2352 by 1568 pixels:
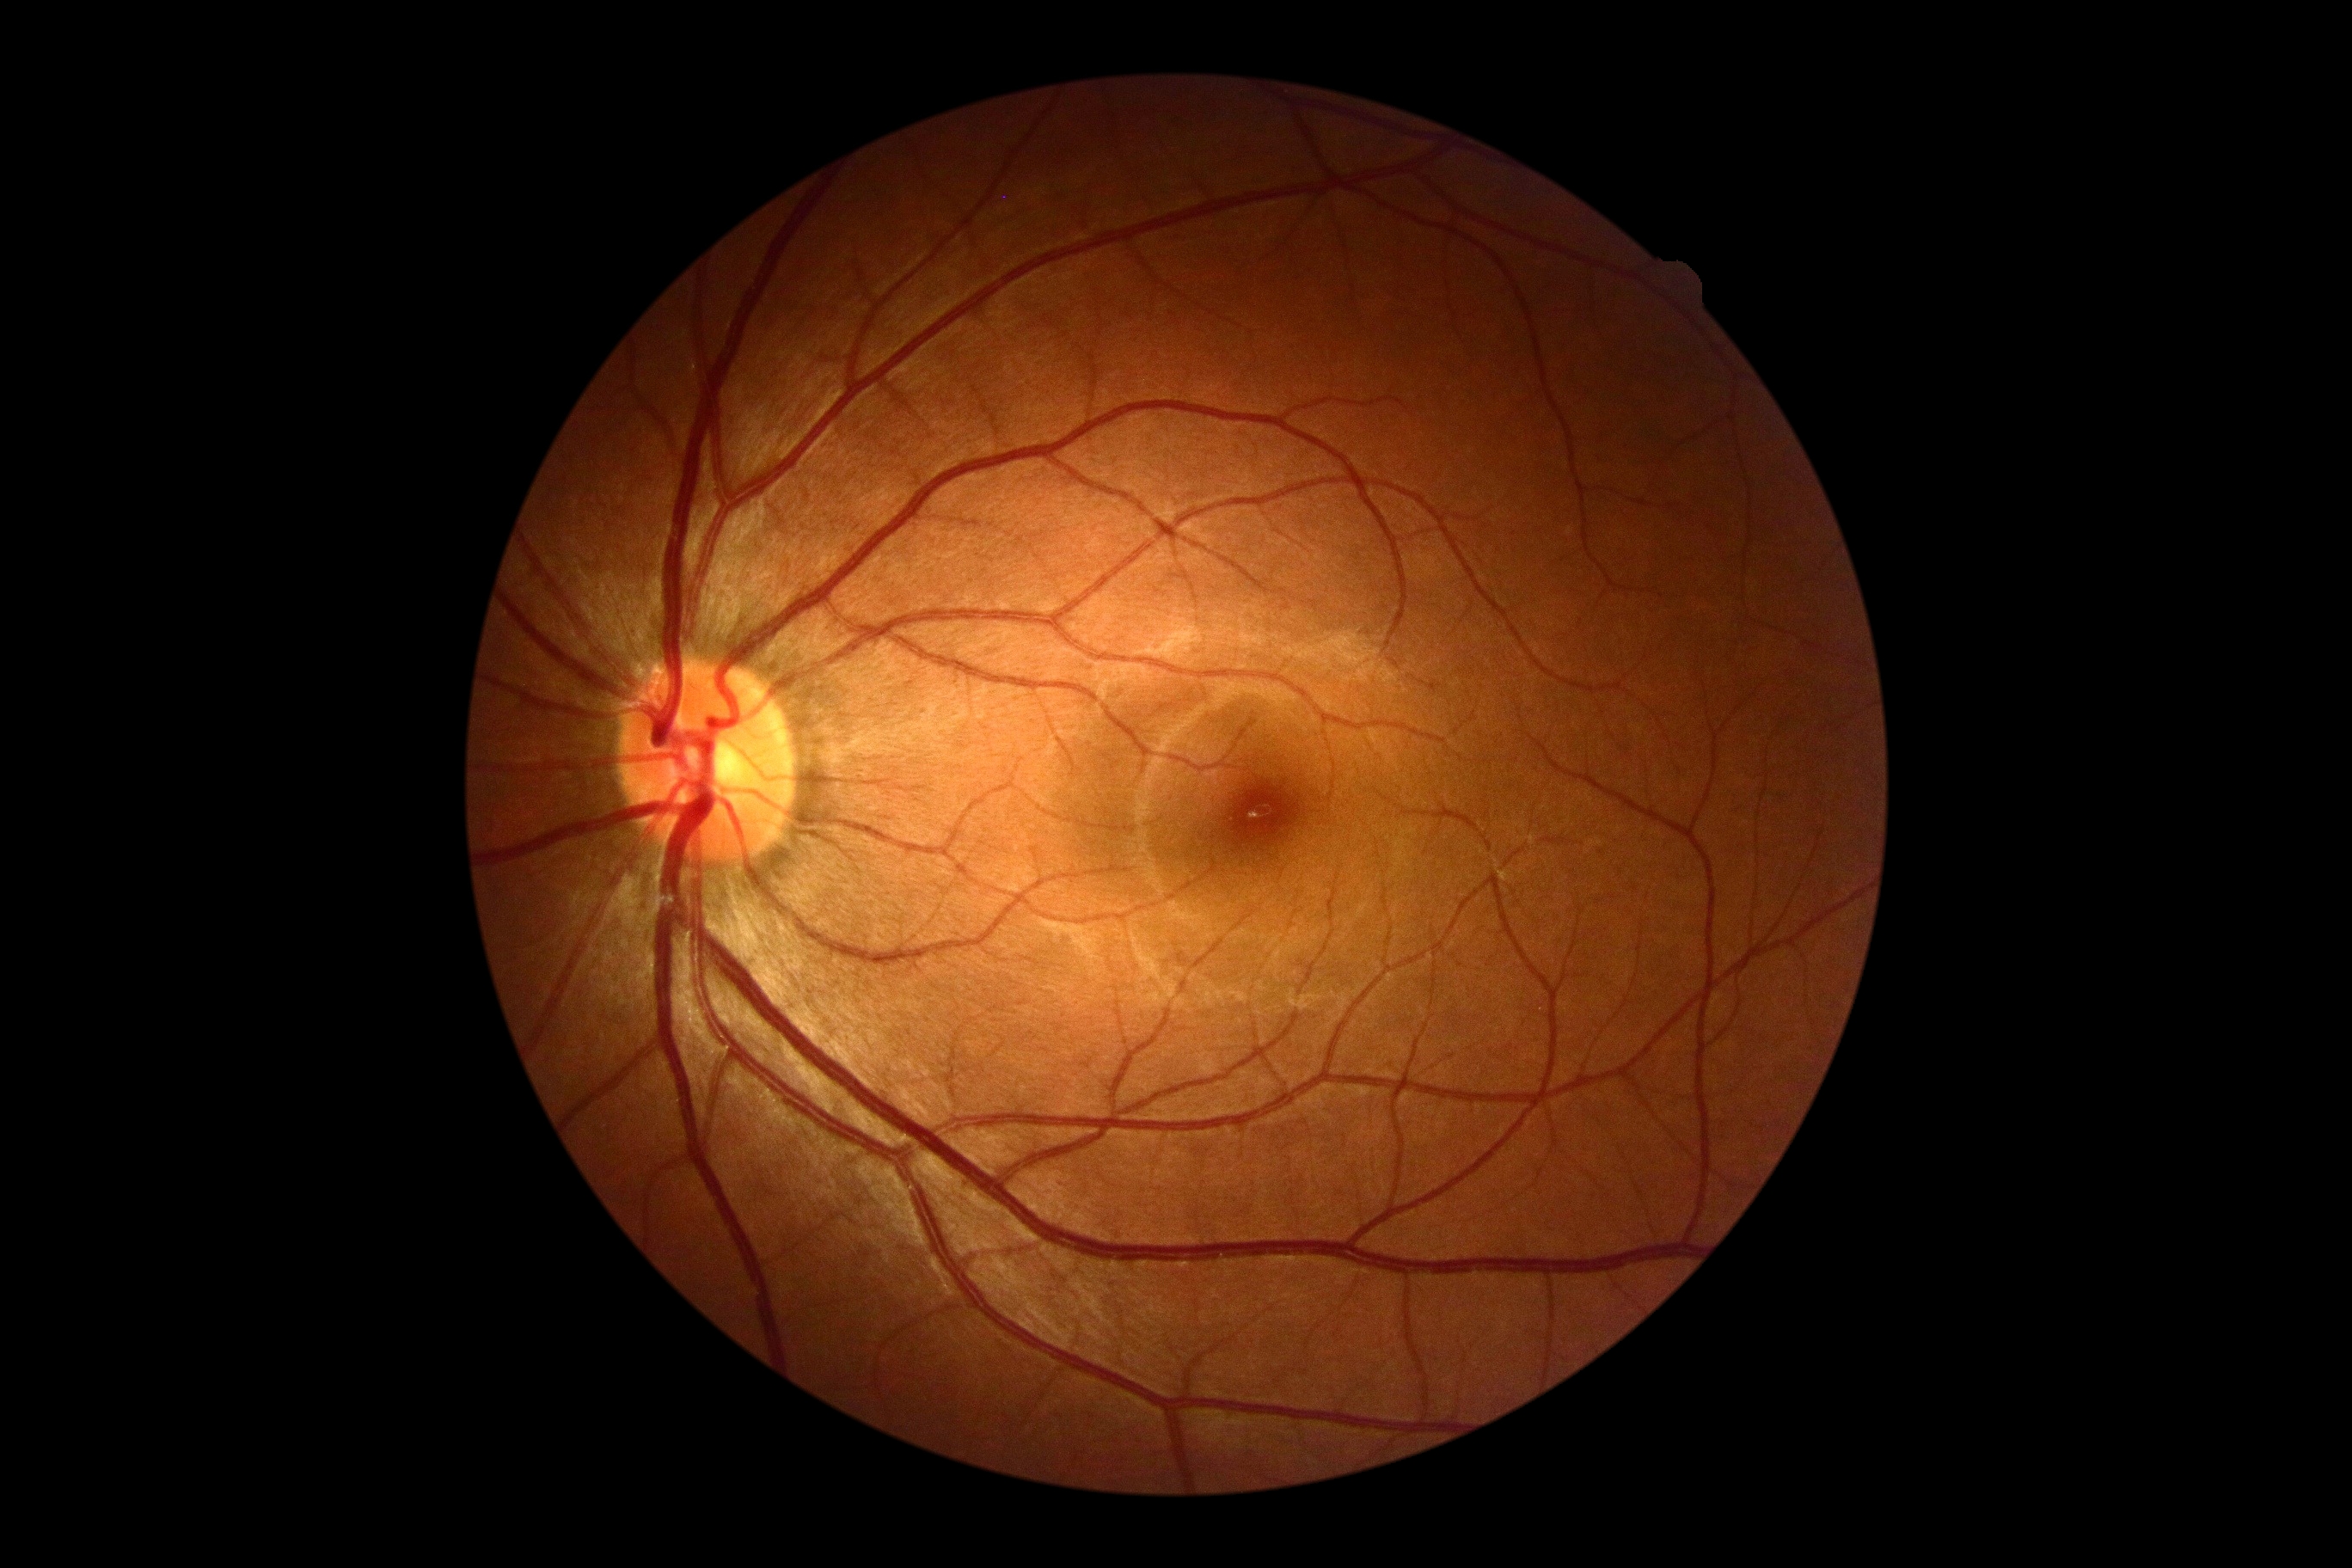 – DR impression: no signs of DR
– DR severity: 0/4